Wide-field fundus photograph from neonatal ROP screening.
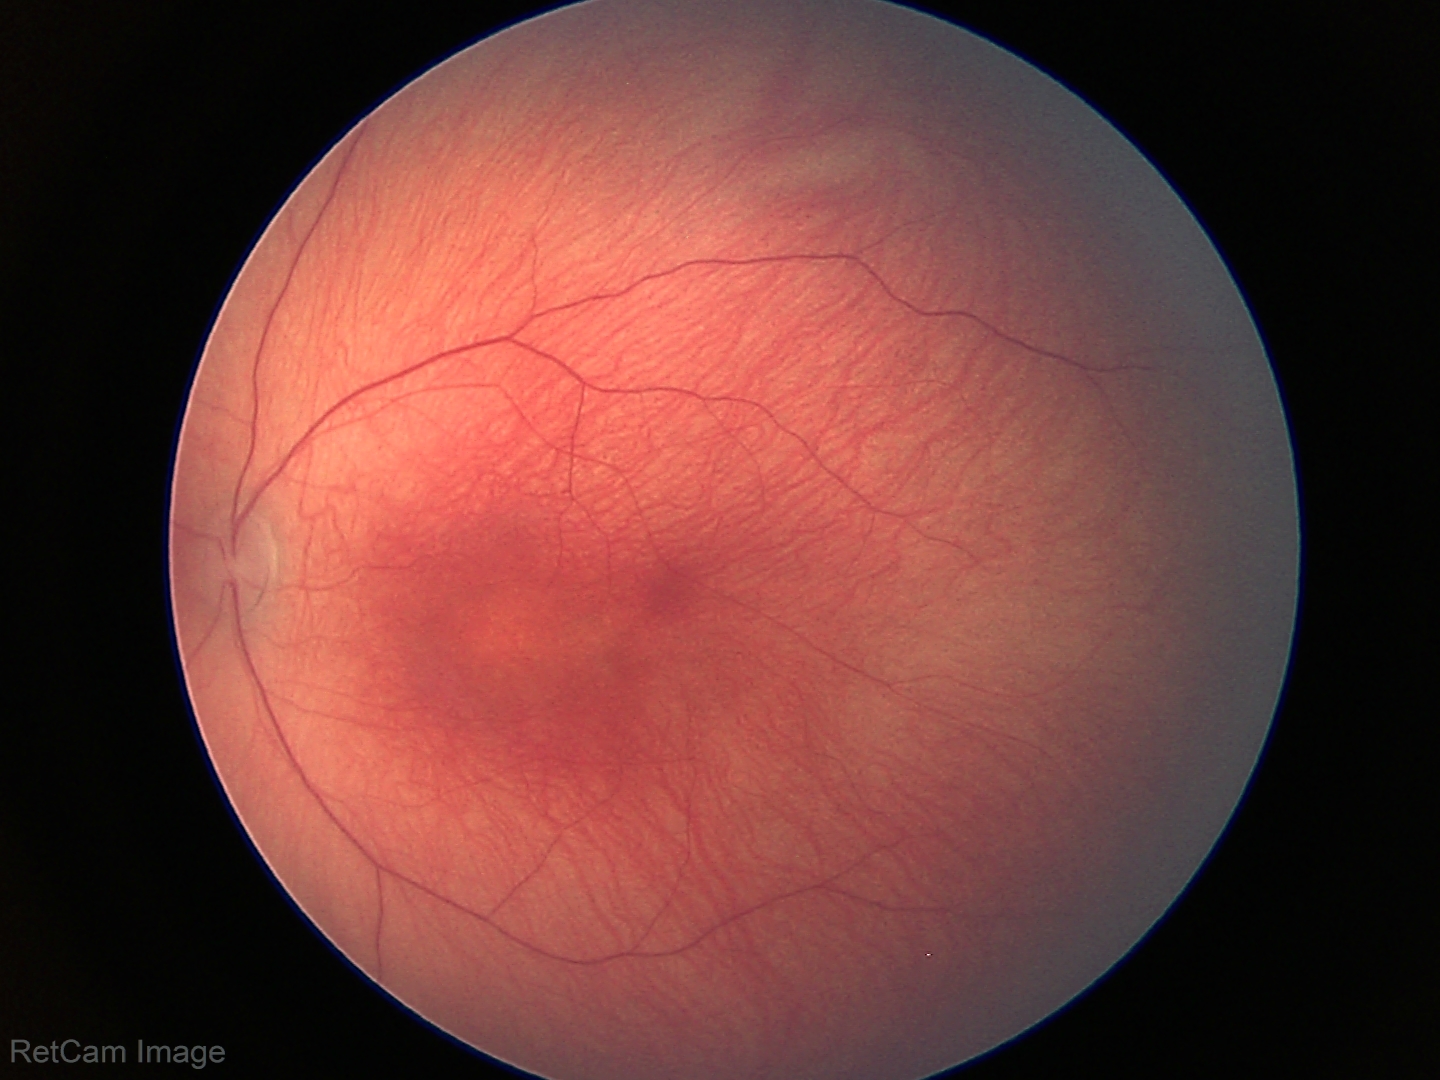

Without plus disease.
Screening series with status post ROP.